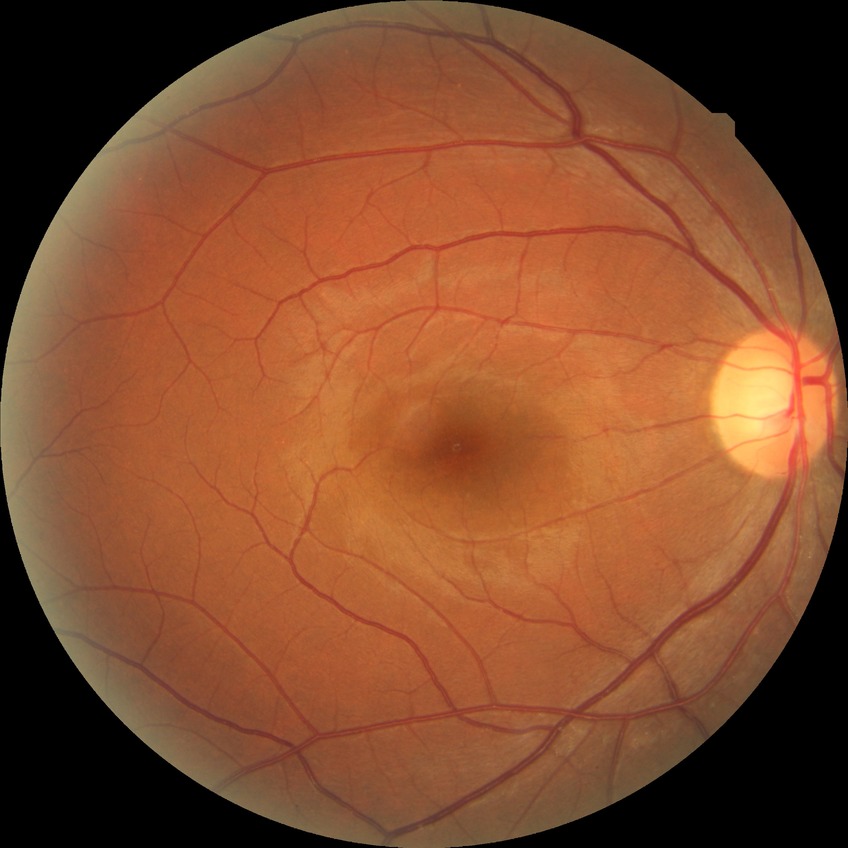
davis_grade: no diabetic retinopathy (NDR)